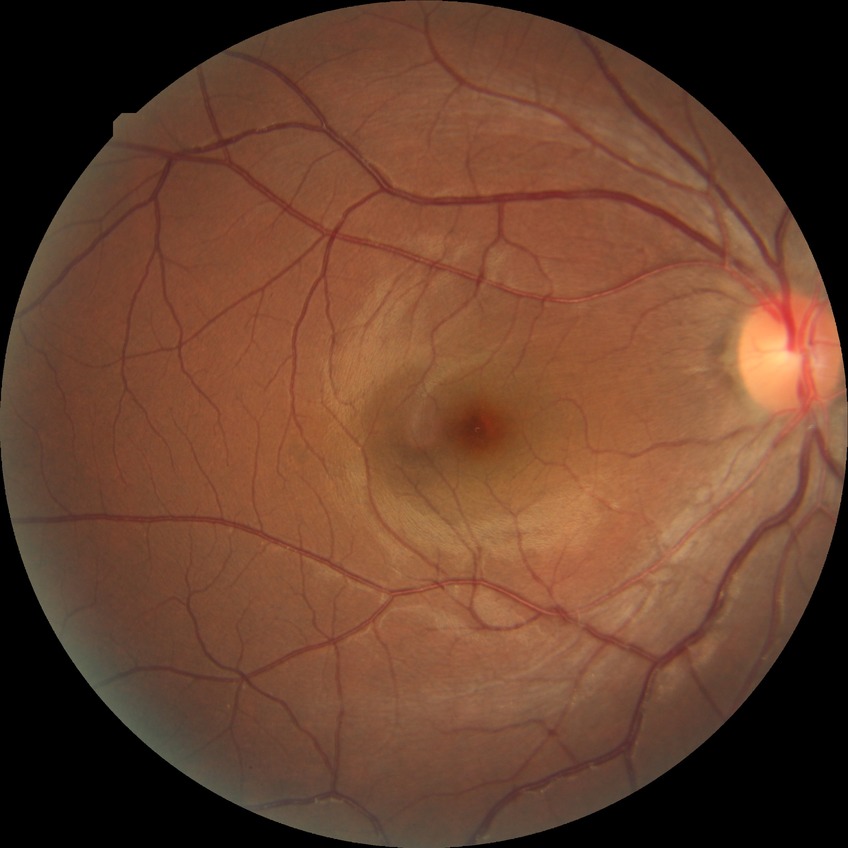

Diabetic retinopathy (DR): no diabetic retinopathy (NDR).